Infant wide-field fundus photograph — 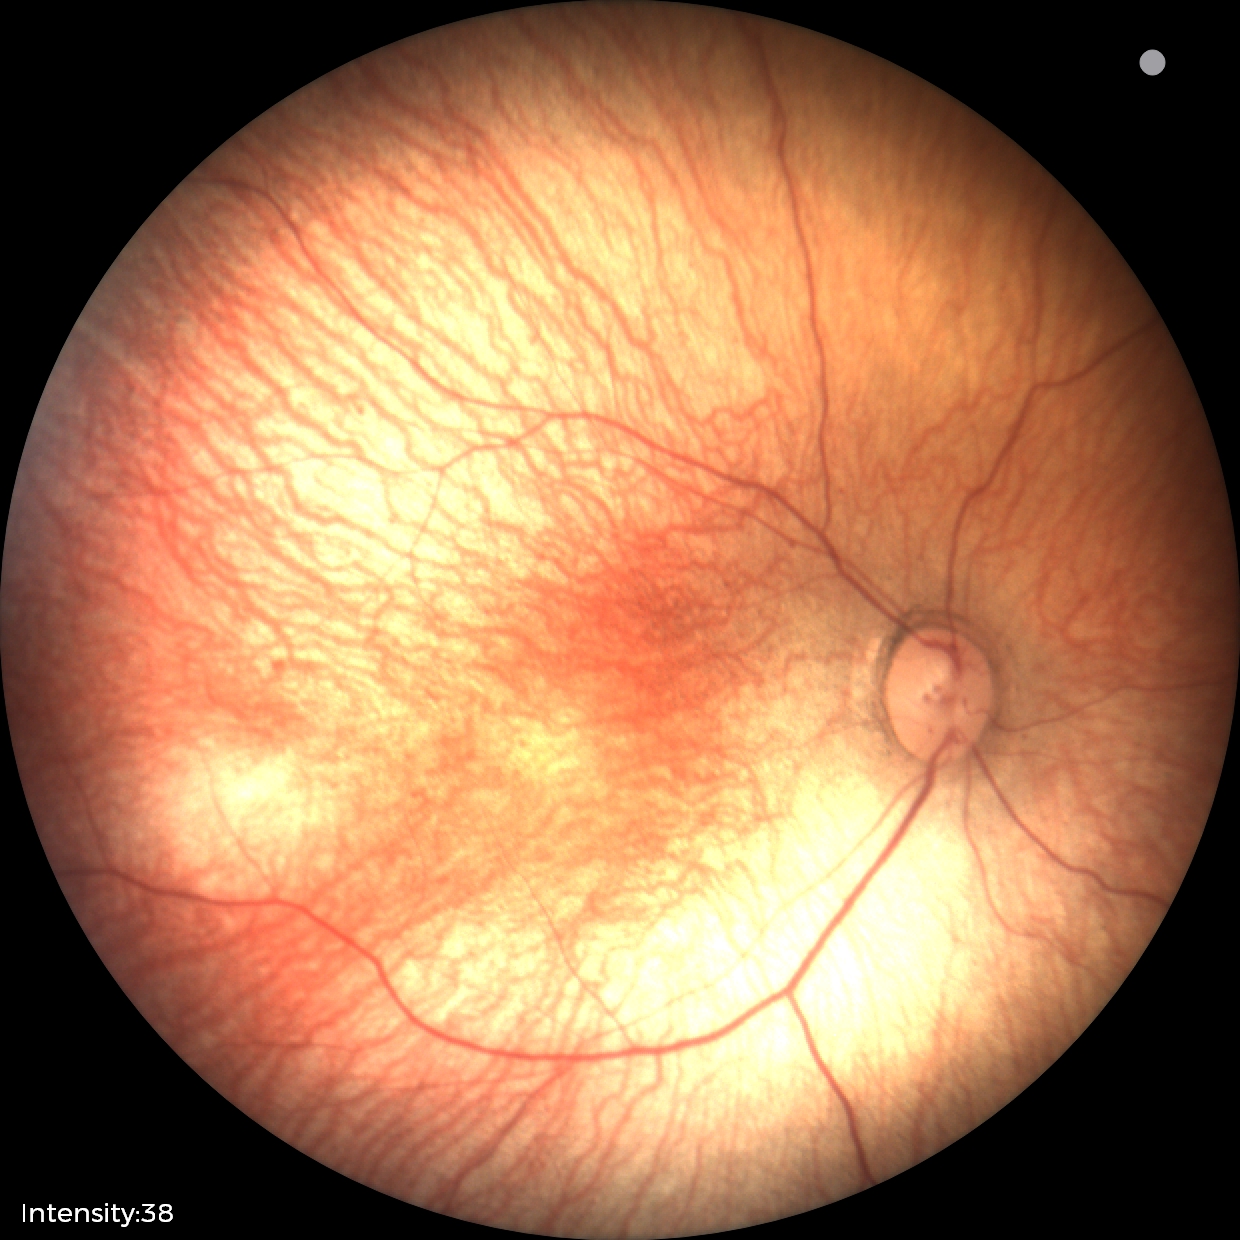

Normal screening examination.